Color fundus image, 2352 x 1568 pixels: 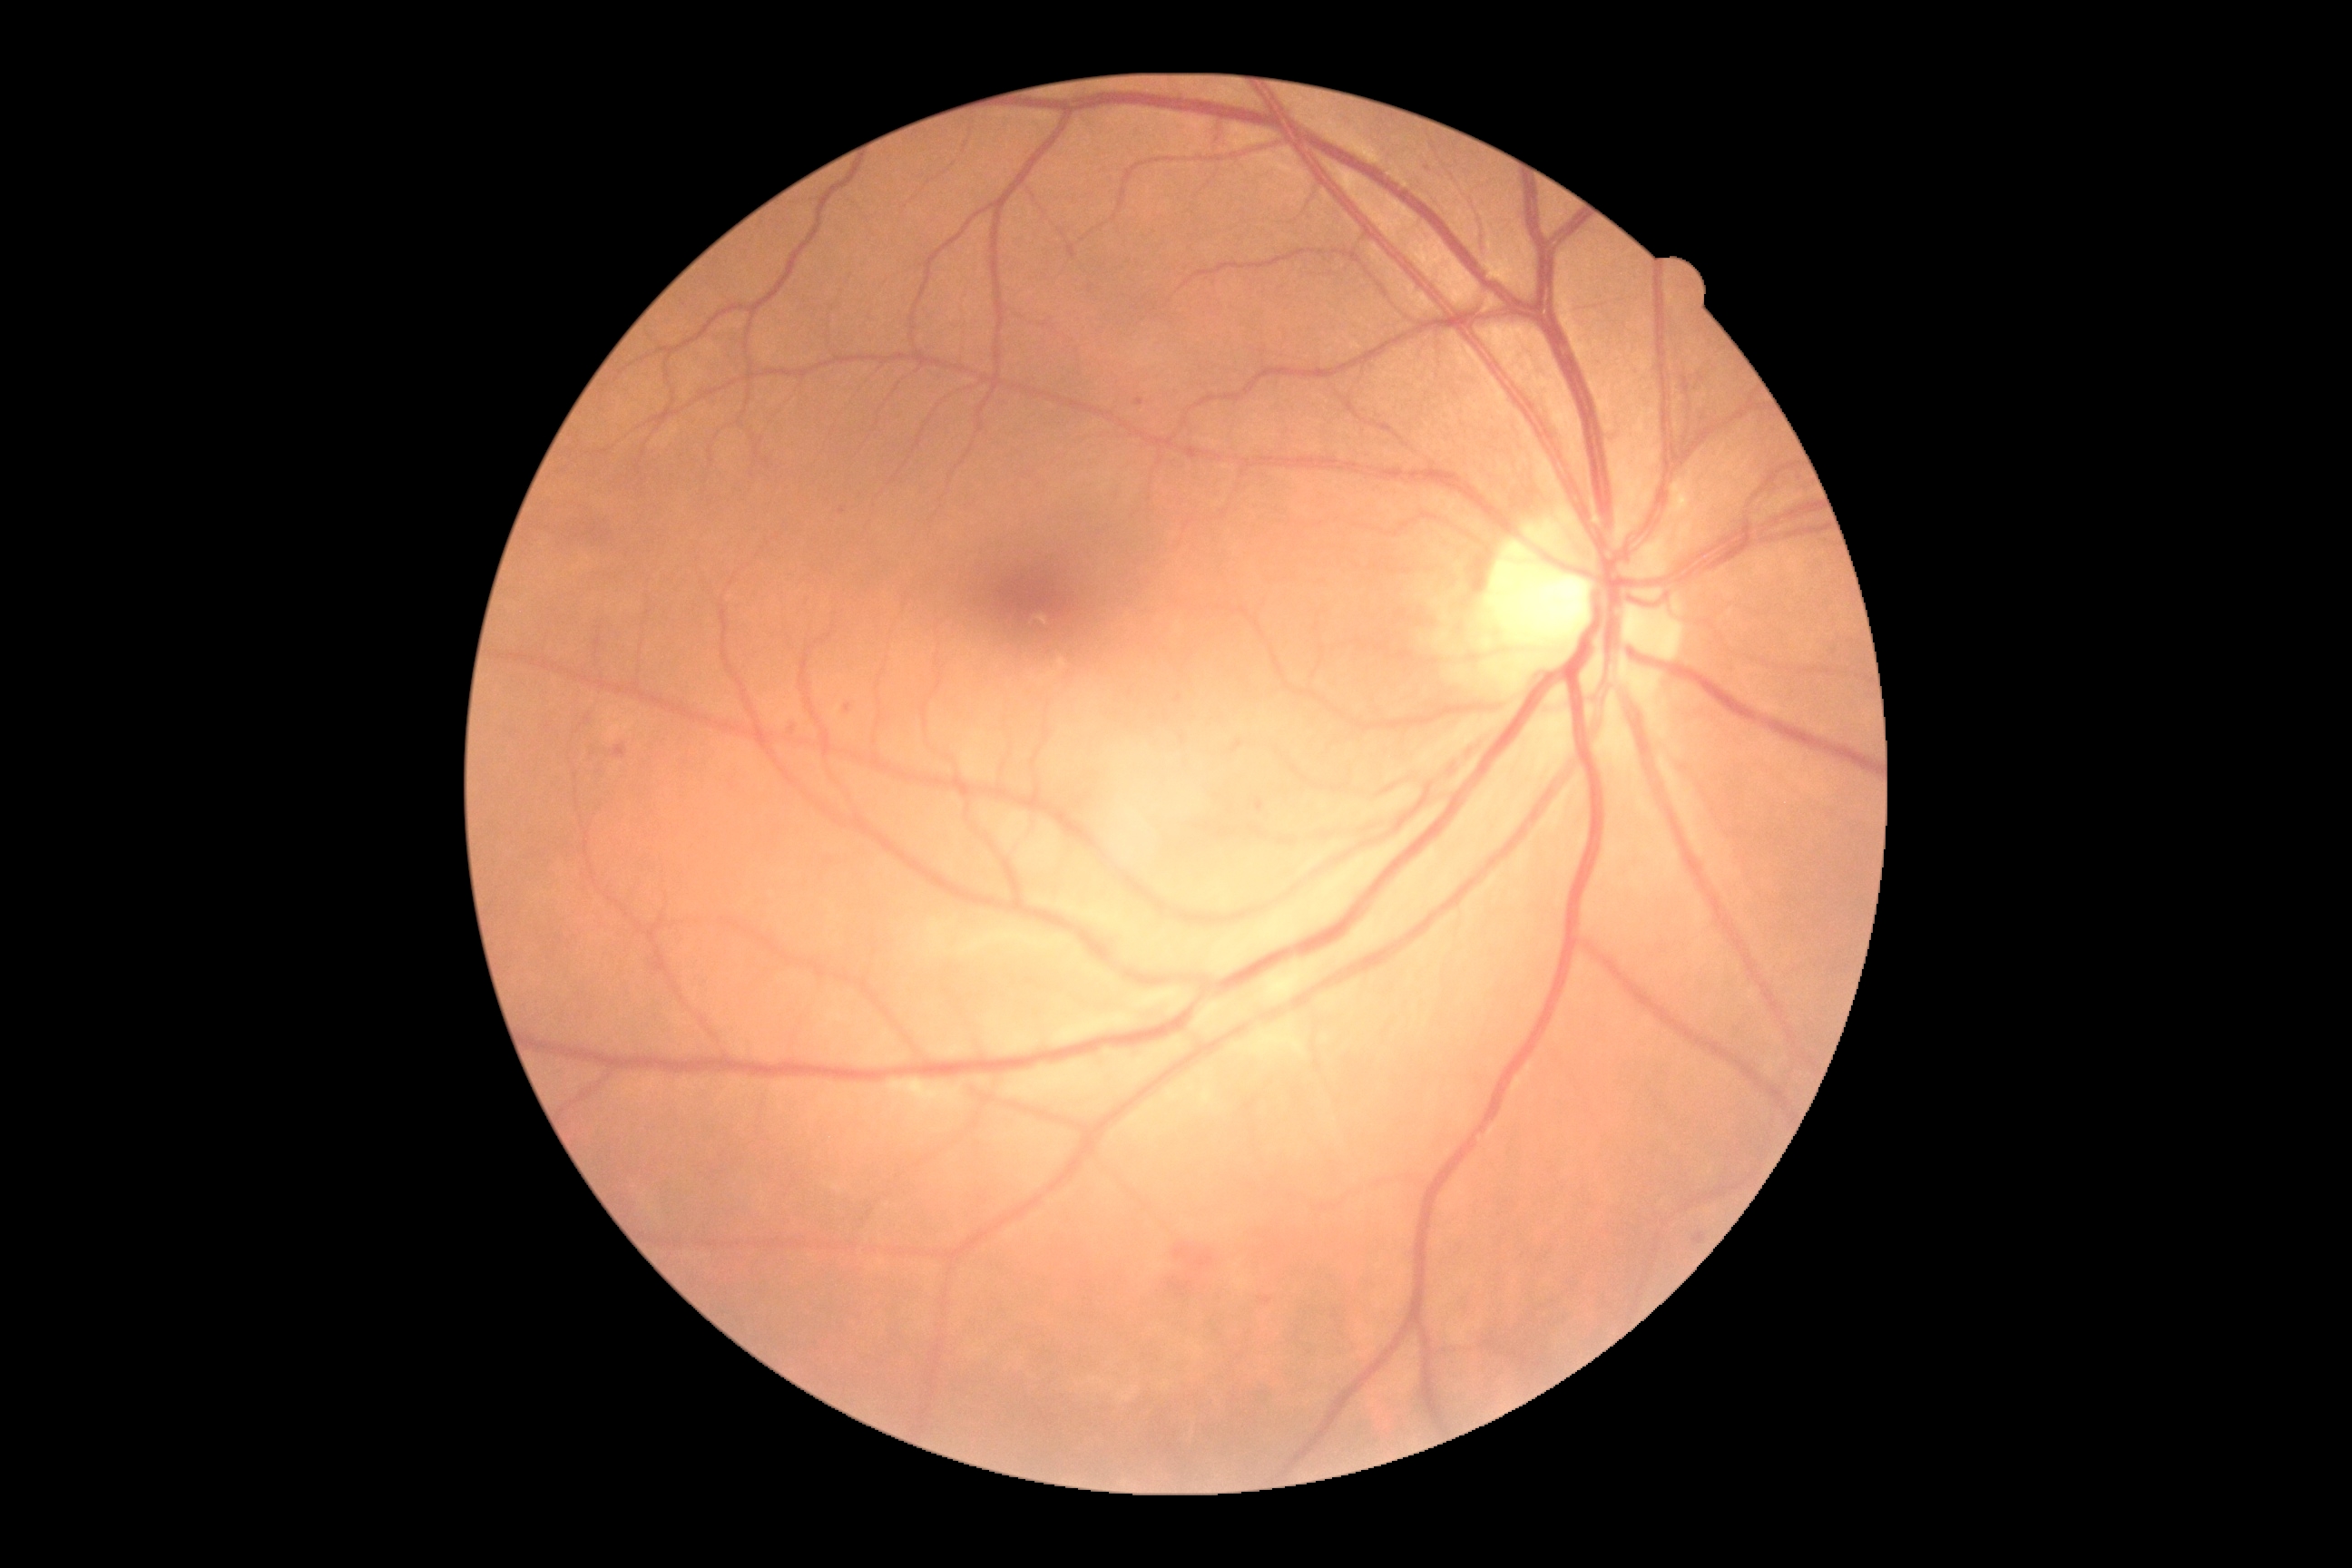

Diabetic retinopathy severity: moderate non-proliferative diabetic retinopathy (grade 2); non-proliferative diabetic retinopathy. No soft exudates identified. Microaneurysms are located at [left=1259, top=1297, right=1271, bottom=1304] | [left=1135, top=400, right=1144, bottom=406] | [left=843, top=705, right=852, bottom=714] | [left=1257, top=801, right=1264, bottom=812]. Small microaneurysms near 842/511 | 793/730 | 1429/170 | 1218/139 | 1179/698. Hemorrhages are located at [left=614, top=745, right=627, bottom=760] | [left=1173, top=1244, right=1191, bottom=1260] | [left=1195, top=1251, right=1215, bottom=1269] | [left=1170, top=1282, right=1191, bottom=1291].